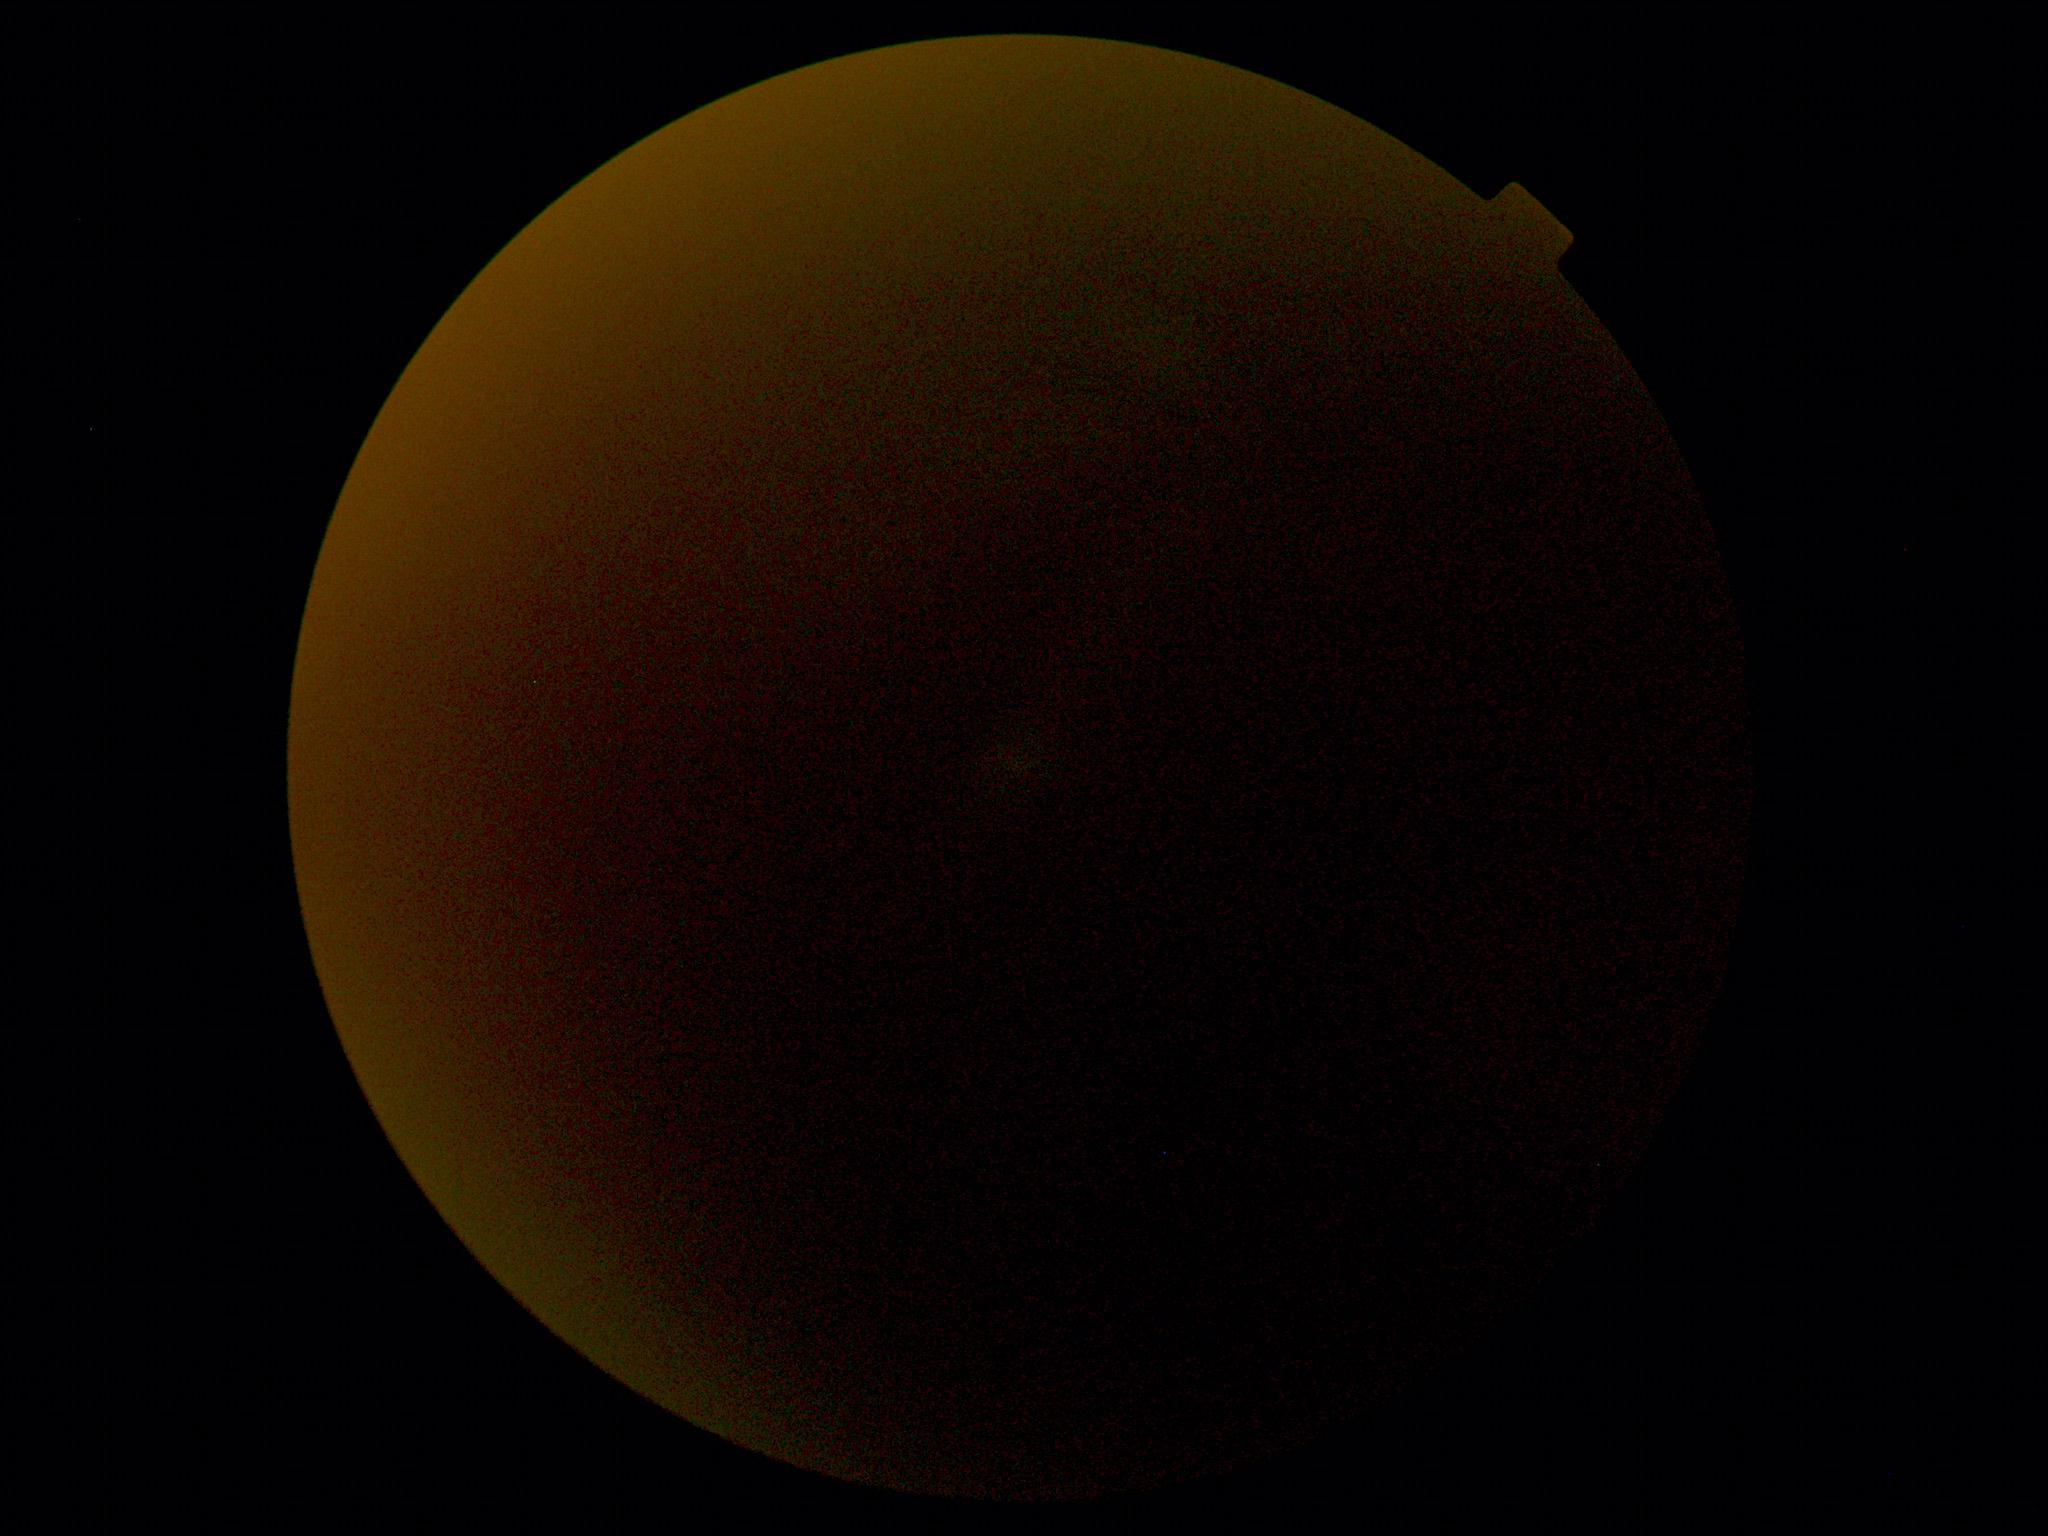

Quality too poor to assess for DR. Diabetic retinopathy (DR): ungradable.